Infant wide-field retinal image. 1240x1240px — 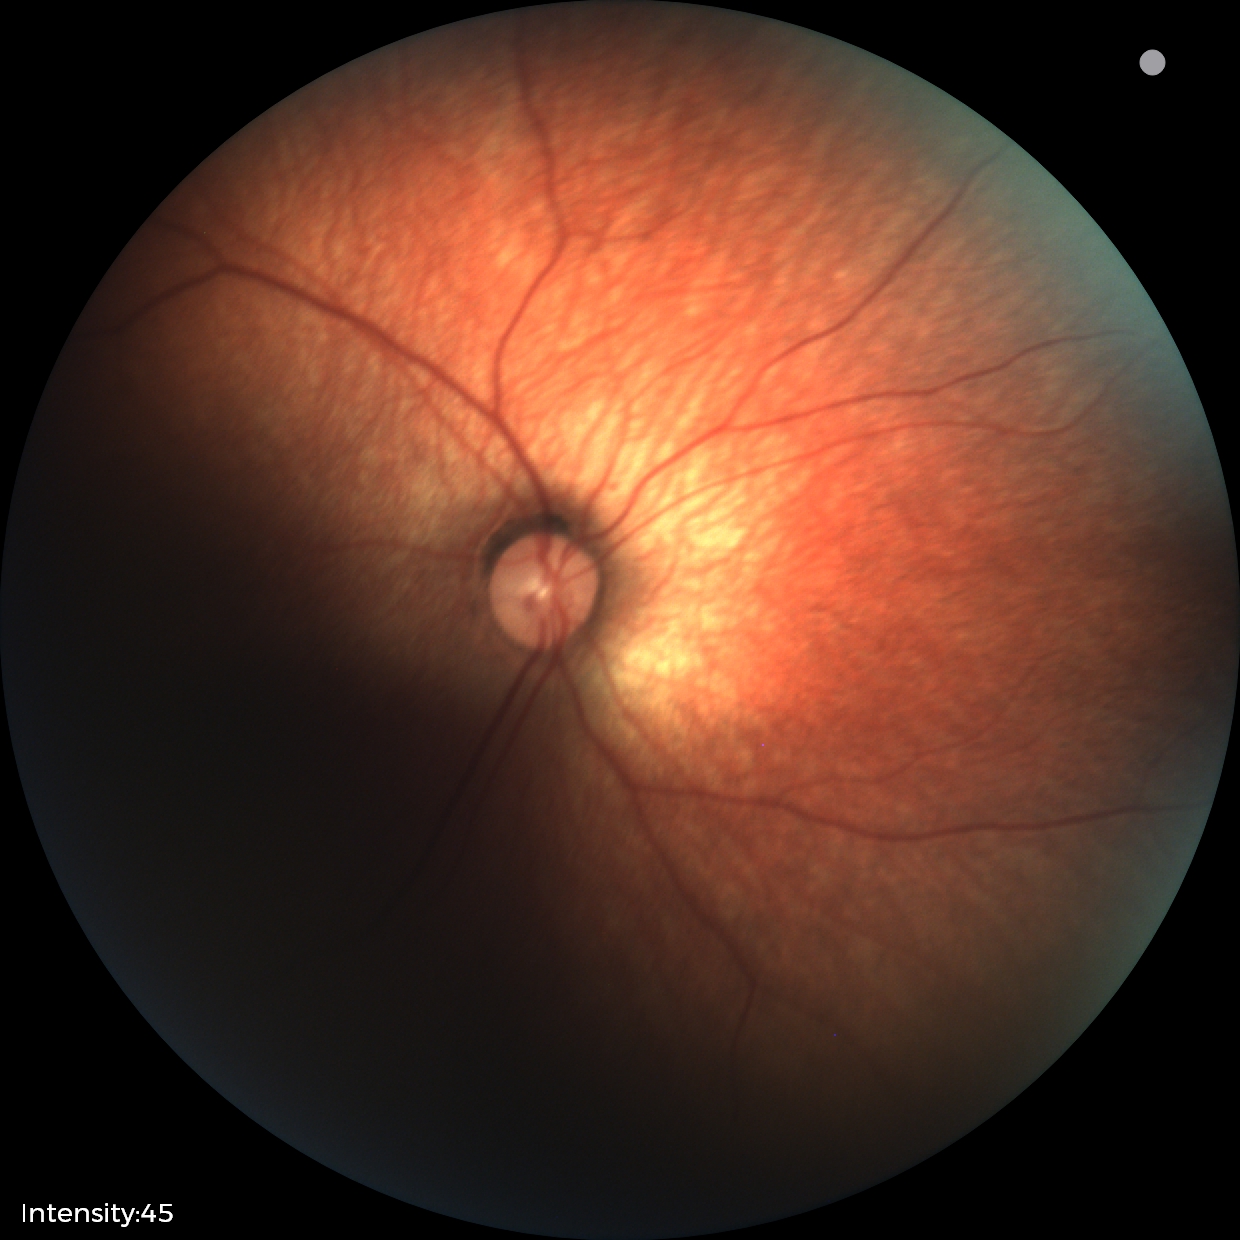

Screening examination diagnosed as physiological.